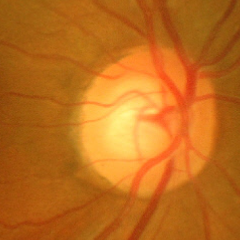 There is evidence of severe glaucomatous damage. Diagnostic criteria: near-total cupping of the optic nerve head, with or without severe visual field loss within the central 10 degrees of fixation.